Pediatric retinal photograph (wide-field) · acquired on the Clarity RetCam 3: 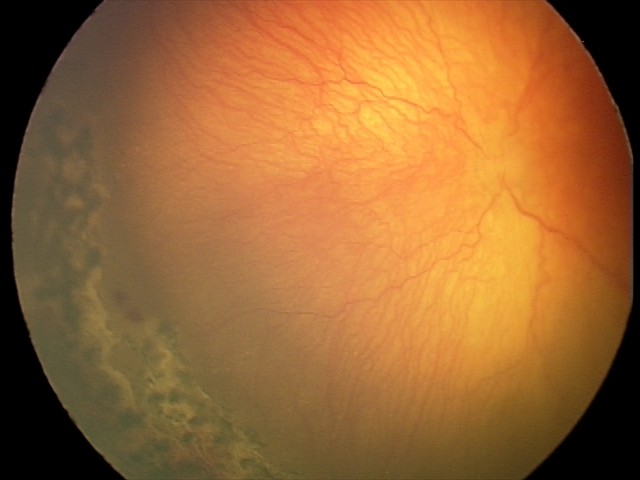
Series diagnosed as aggressive retinopathy of prematurity (A-ROP).
Plus disease was diagnosed.